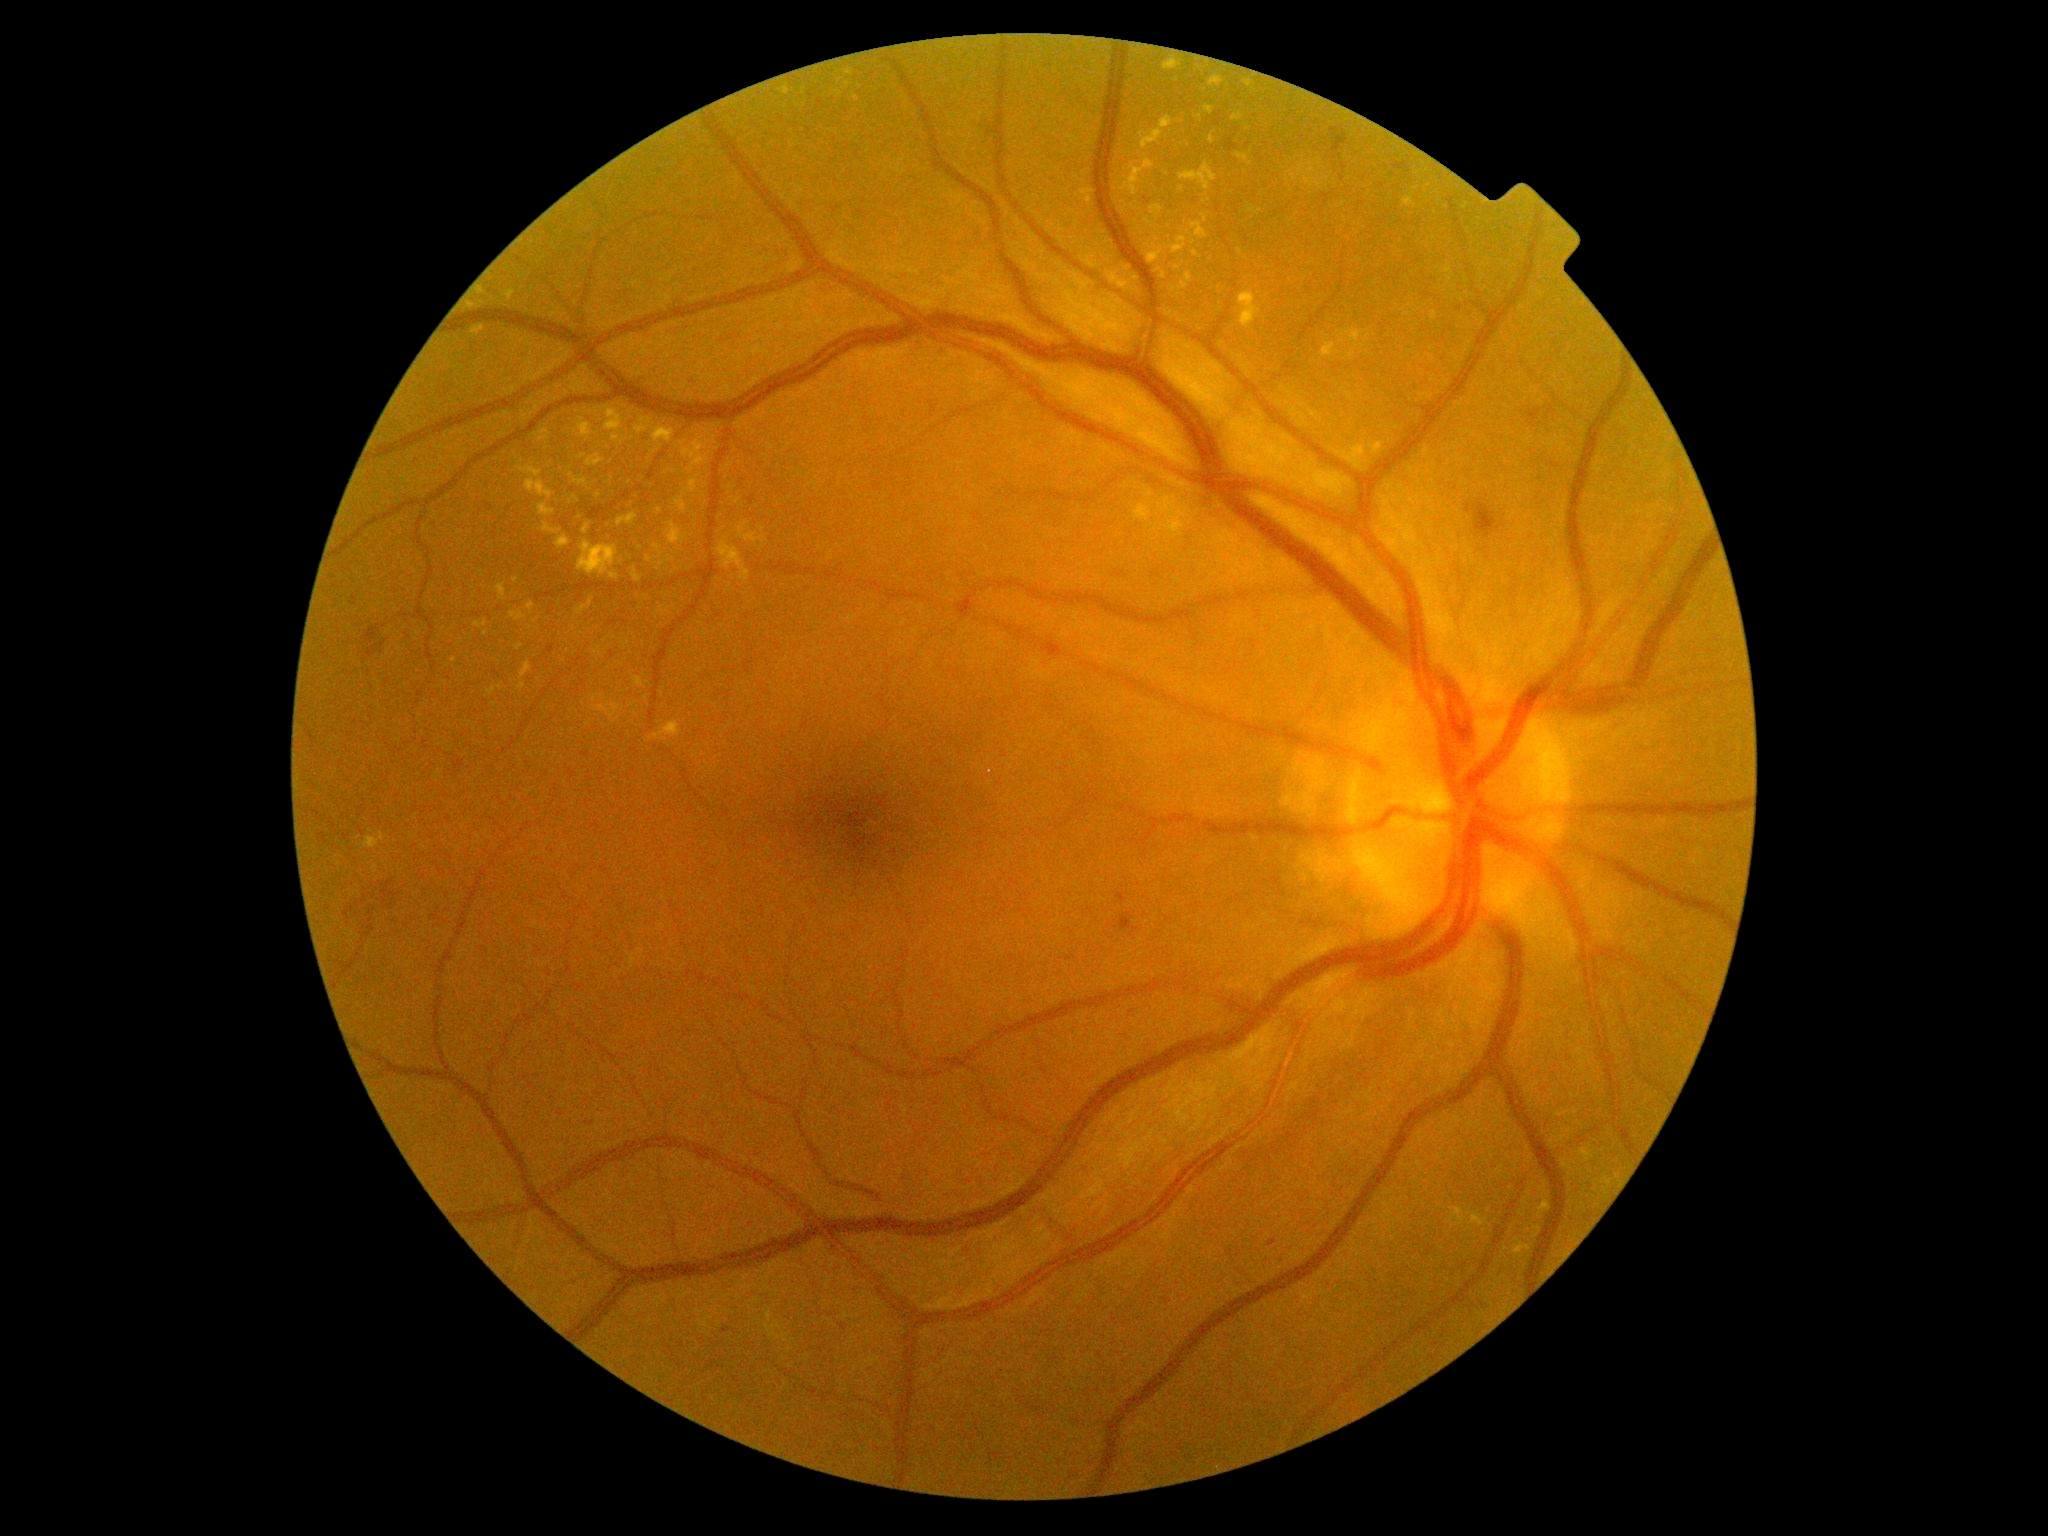

DR severity: 2/4 — more than just microaneurysms but less than severe NPDR; non-proliferative diabetic retinopathy. EXs include [518, 684, 526, 693]; [528, 602, 536, 614]; [503, 290, 516, 301]; [1450, 1208, 1467, 1227]; [1163, 57, 1182, 70]; [739, 522, 767, 545]; [653, 426, 675, 443]; [521, 661, 532, 679]; [1202, 215, 1208, 224]; [654, 545, 663, 558]; [1140, 118, 1173, 151]. Small EXs near 606, 642; 643, 422; 1121, 279; 710, 401; 570, 502; 1313, 171; 535, 622; 650, 560.